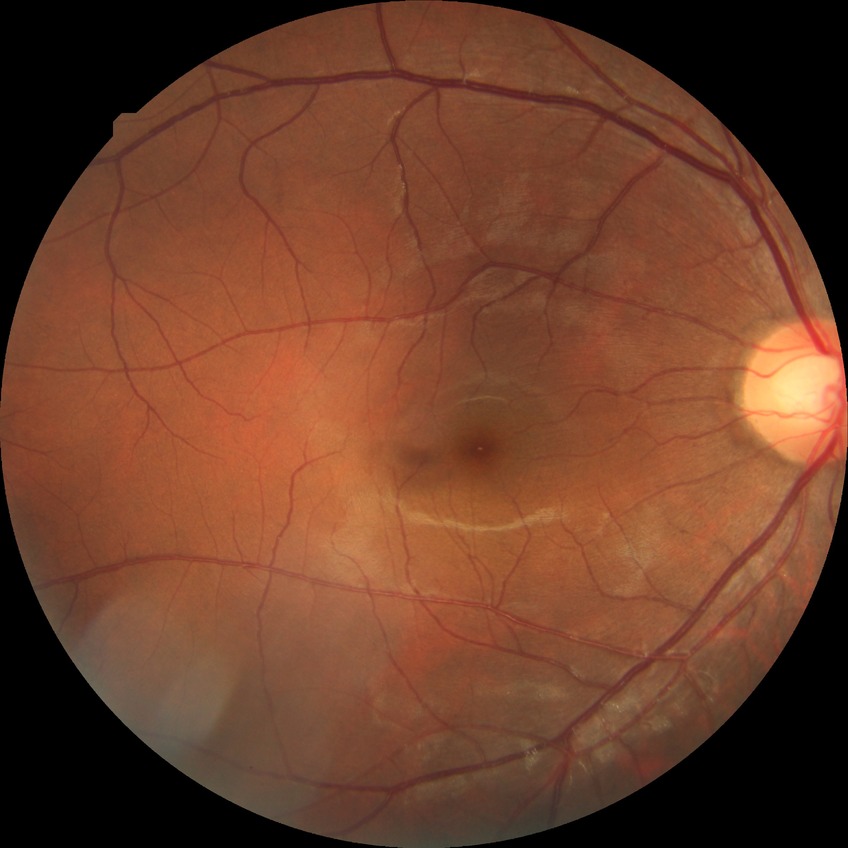 Modified Davis grading: no diabetic retinopathy.